848 x 848 pixels. Davis DR grading. Nonmydriatic — 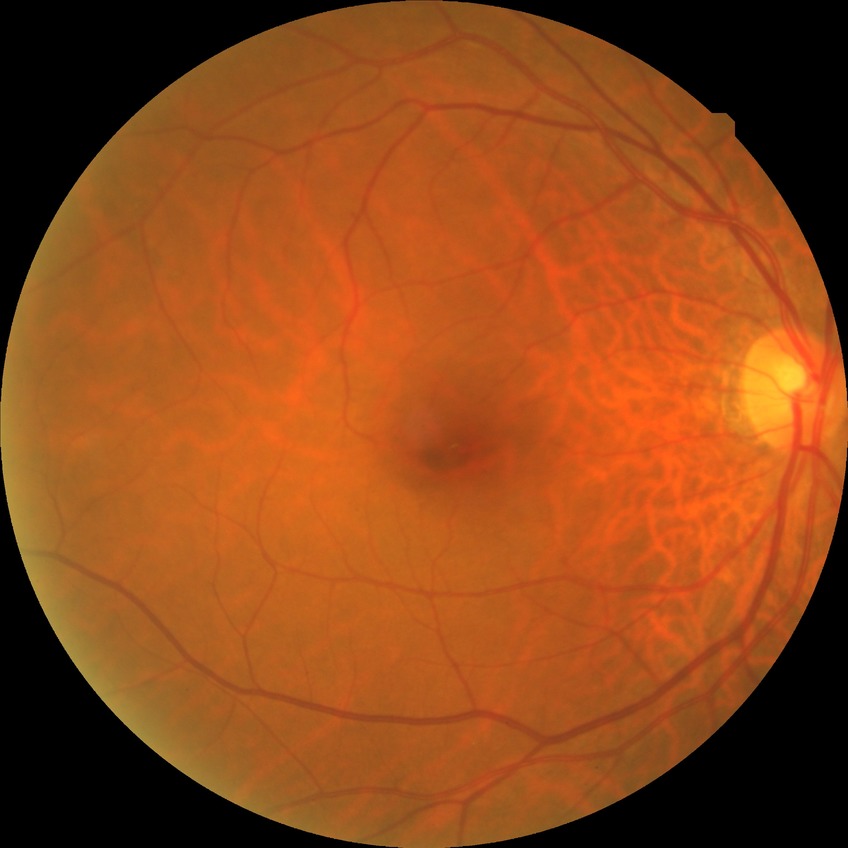

DR grade: SDR.
The retinopathy is classified as non-proliferative diabetic retinopathy.